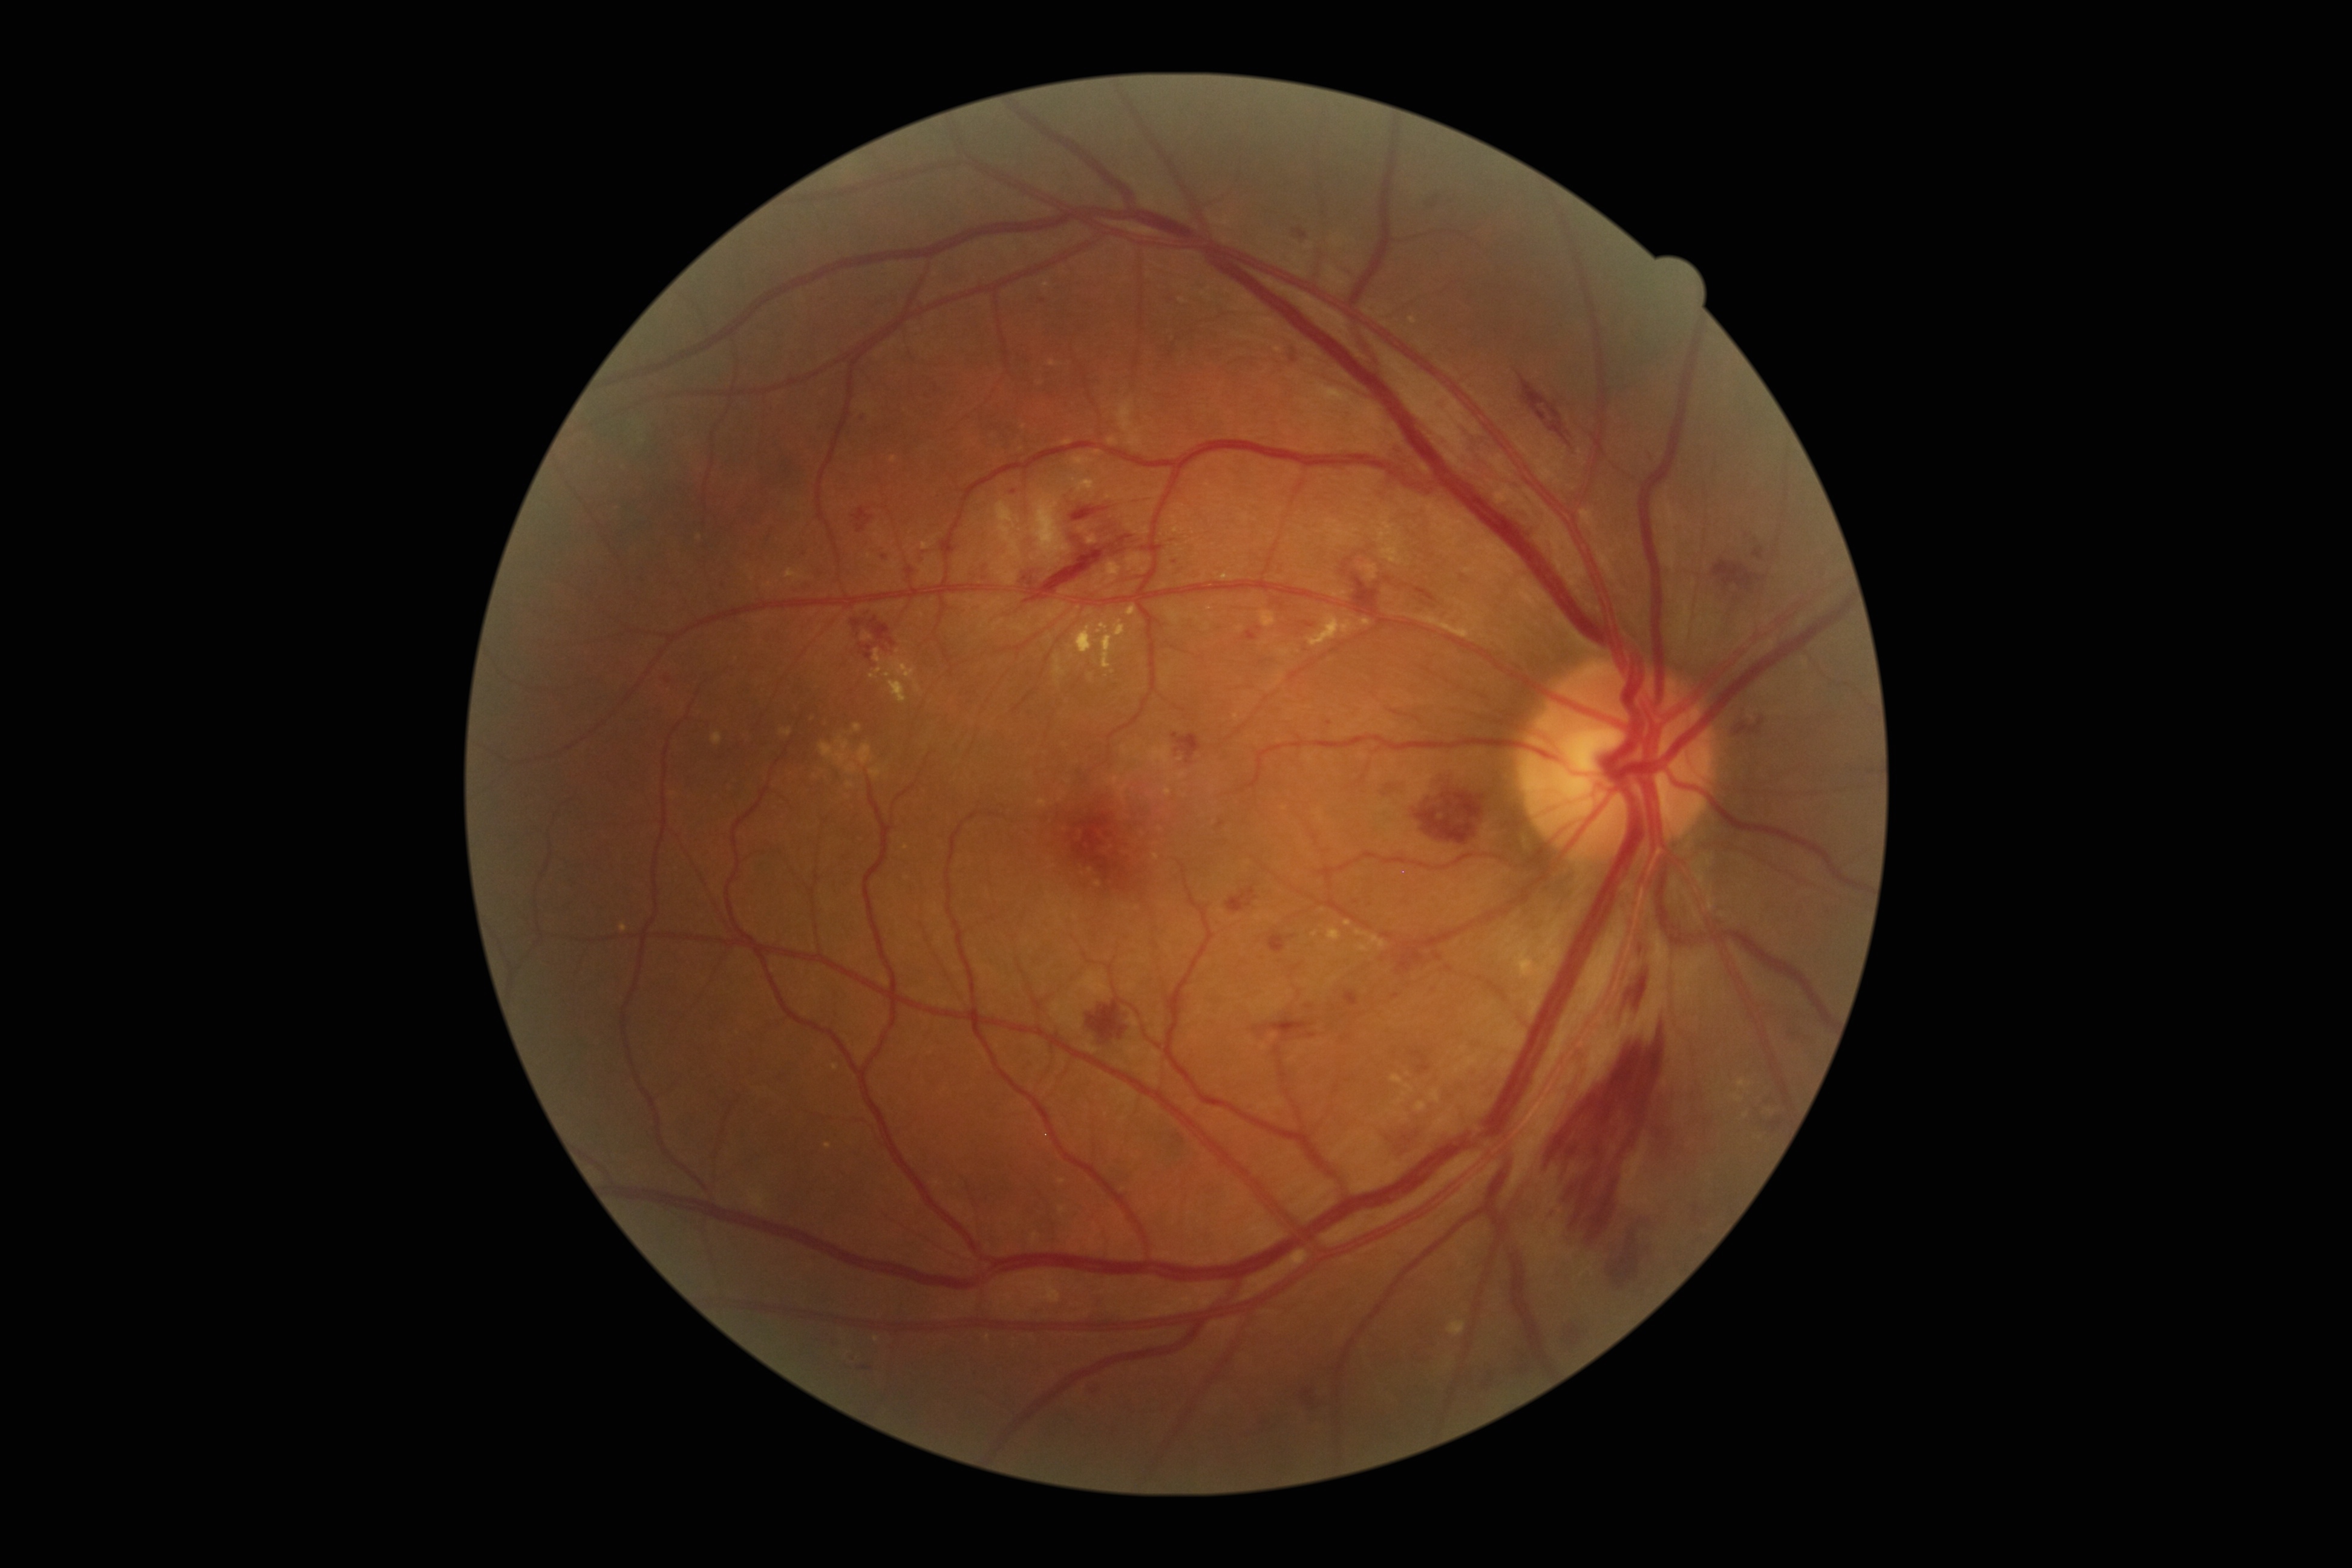 Retinopathy grade: 2 (moderate NPDR).